Wide-field fundus image from infant ROP screening — 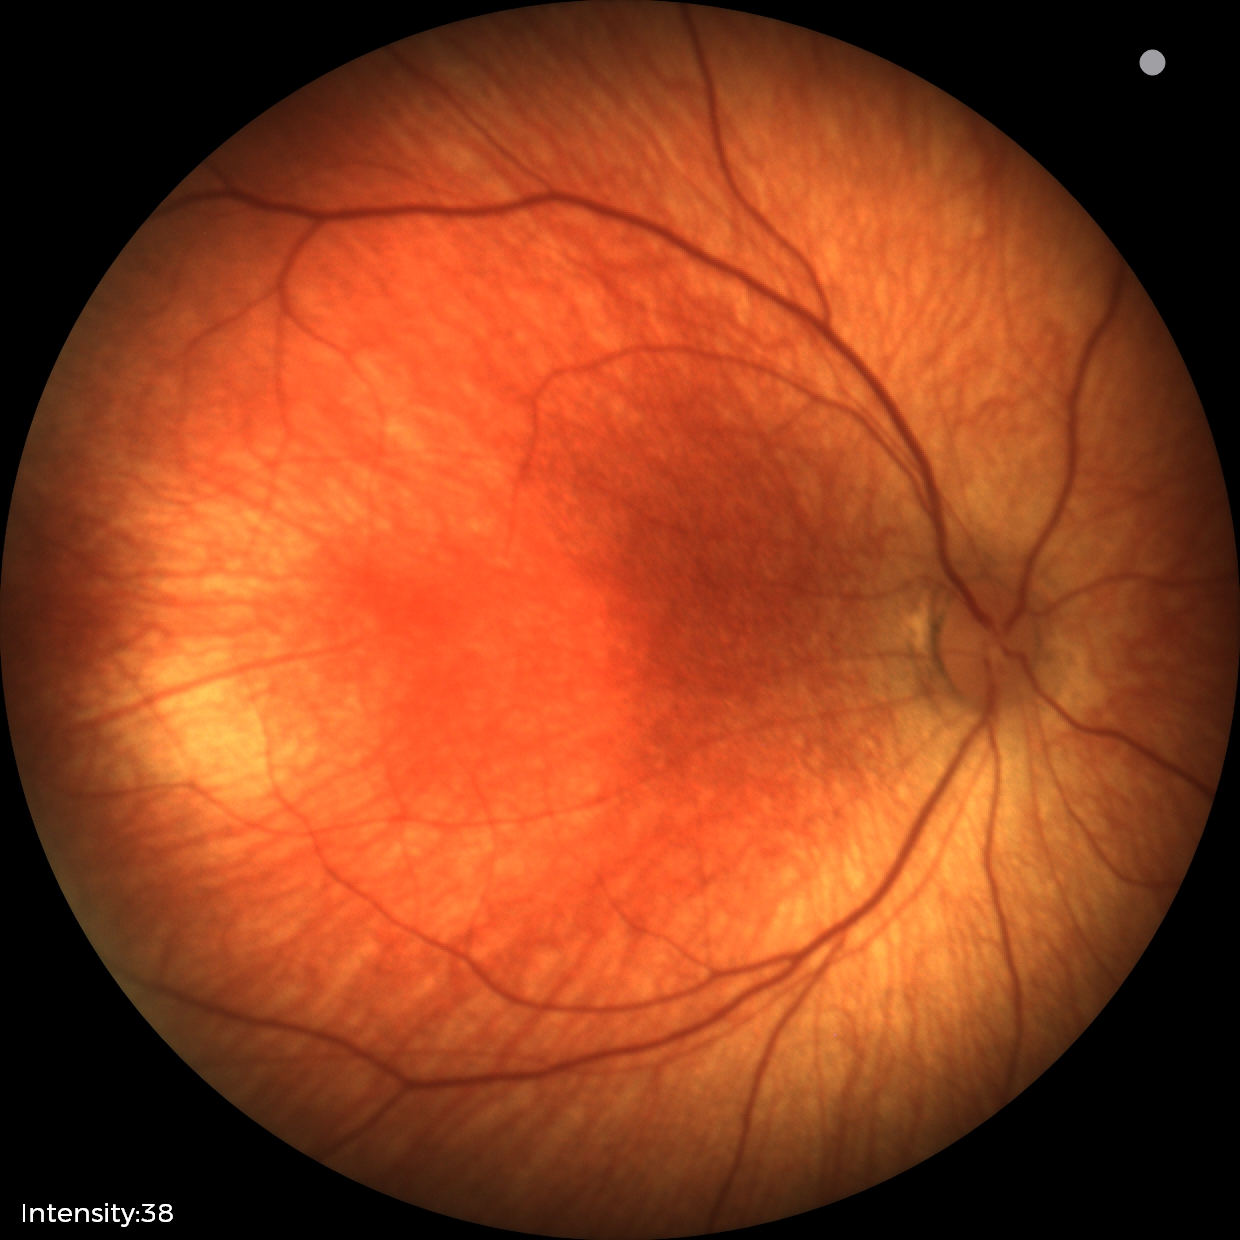 Impression: physiological appearance with no retinal pathology.